Image size 848x848
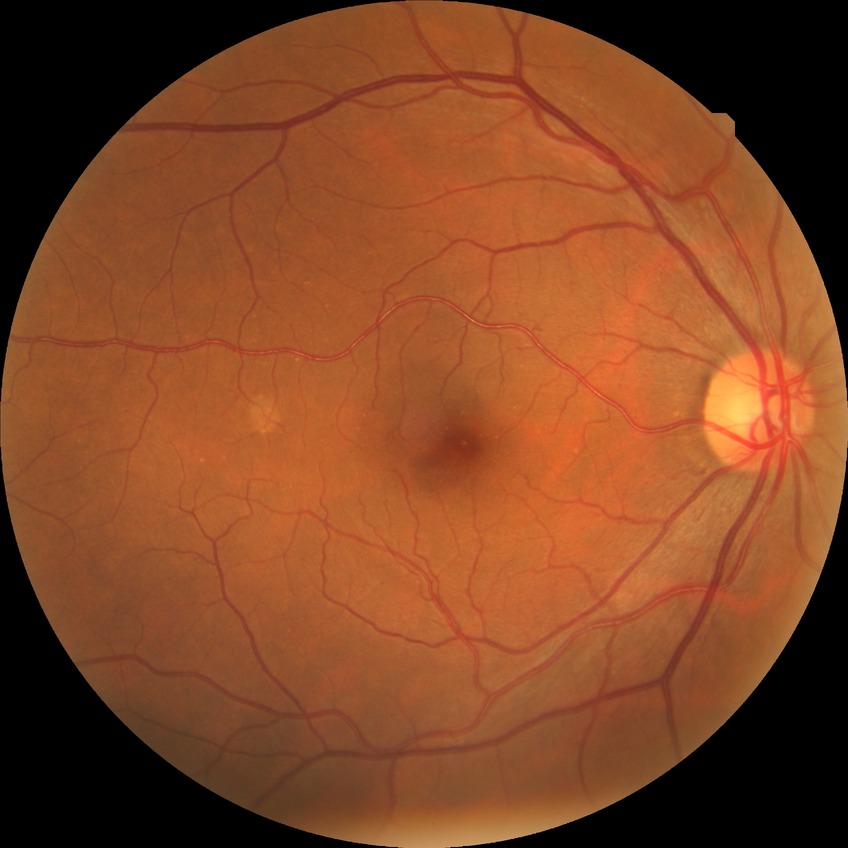
Retinopathy stage: no diabetic retinopathy.